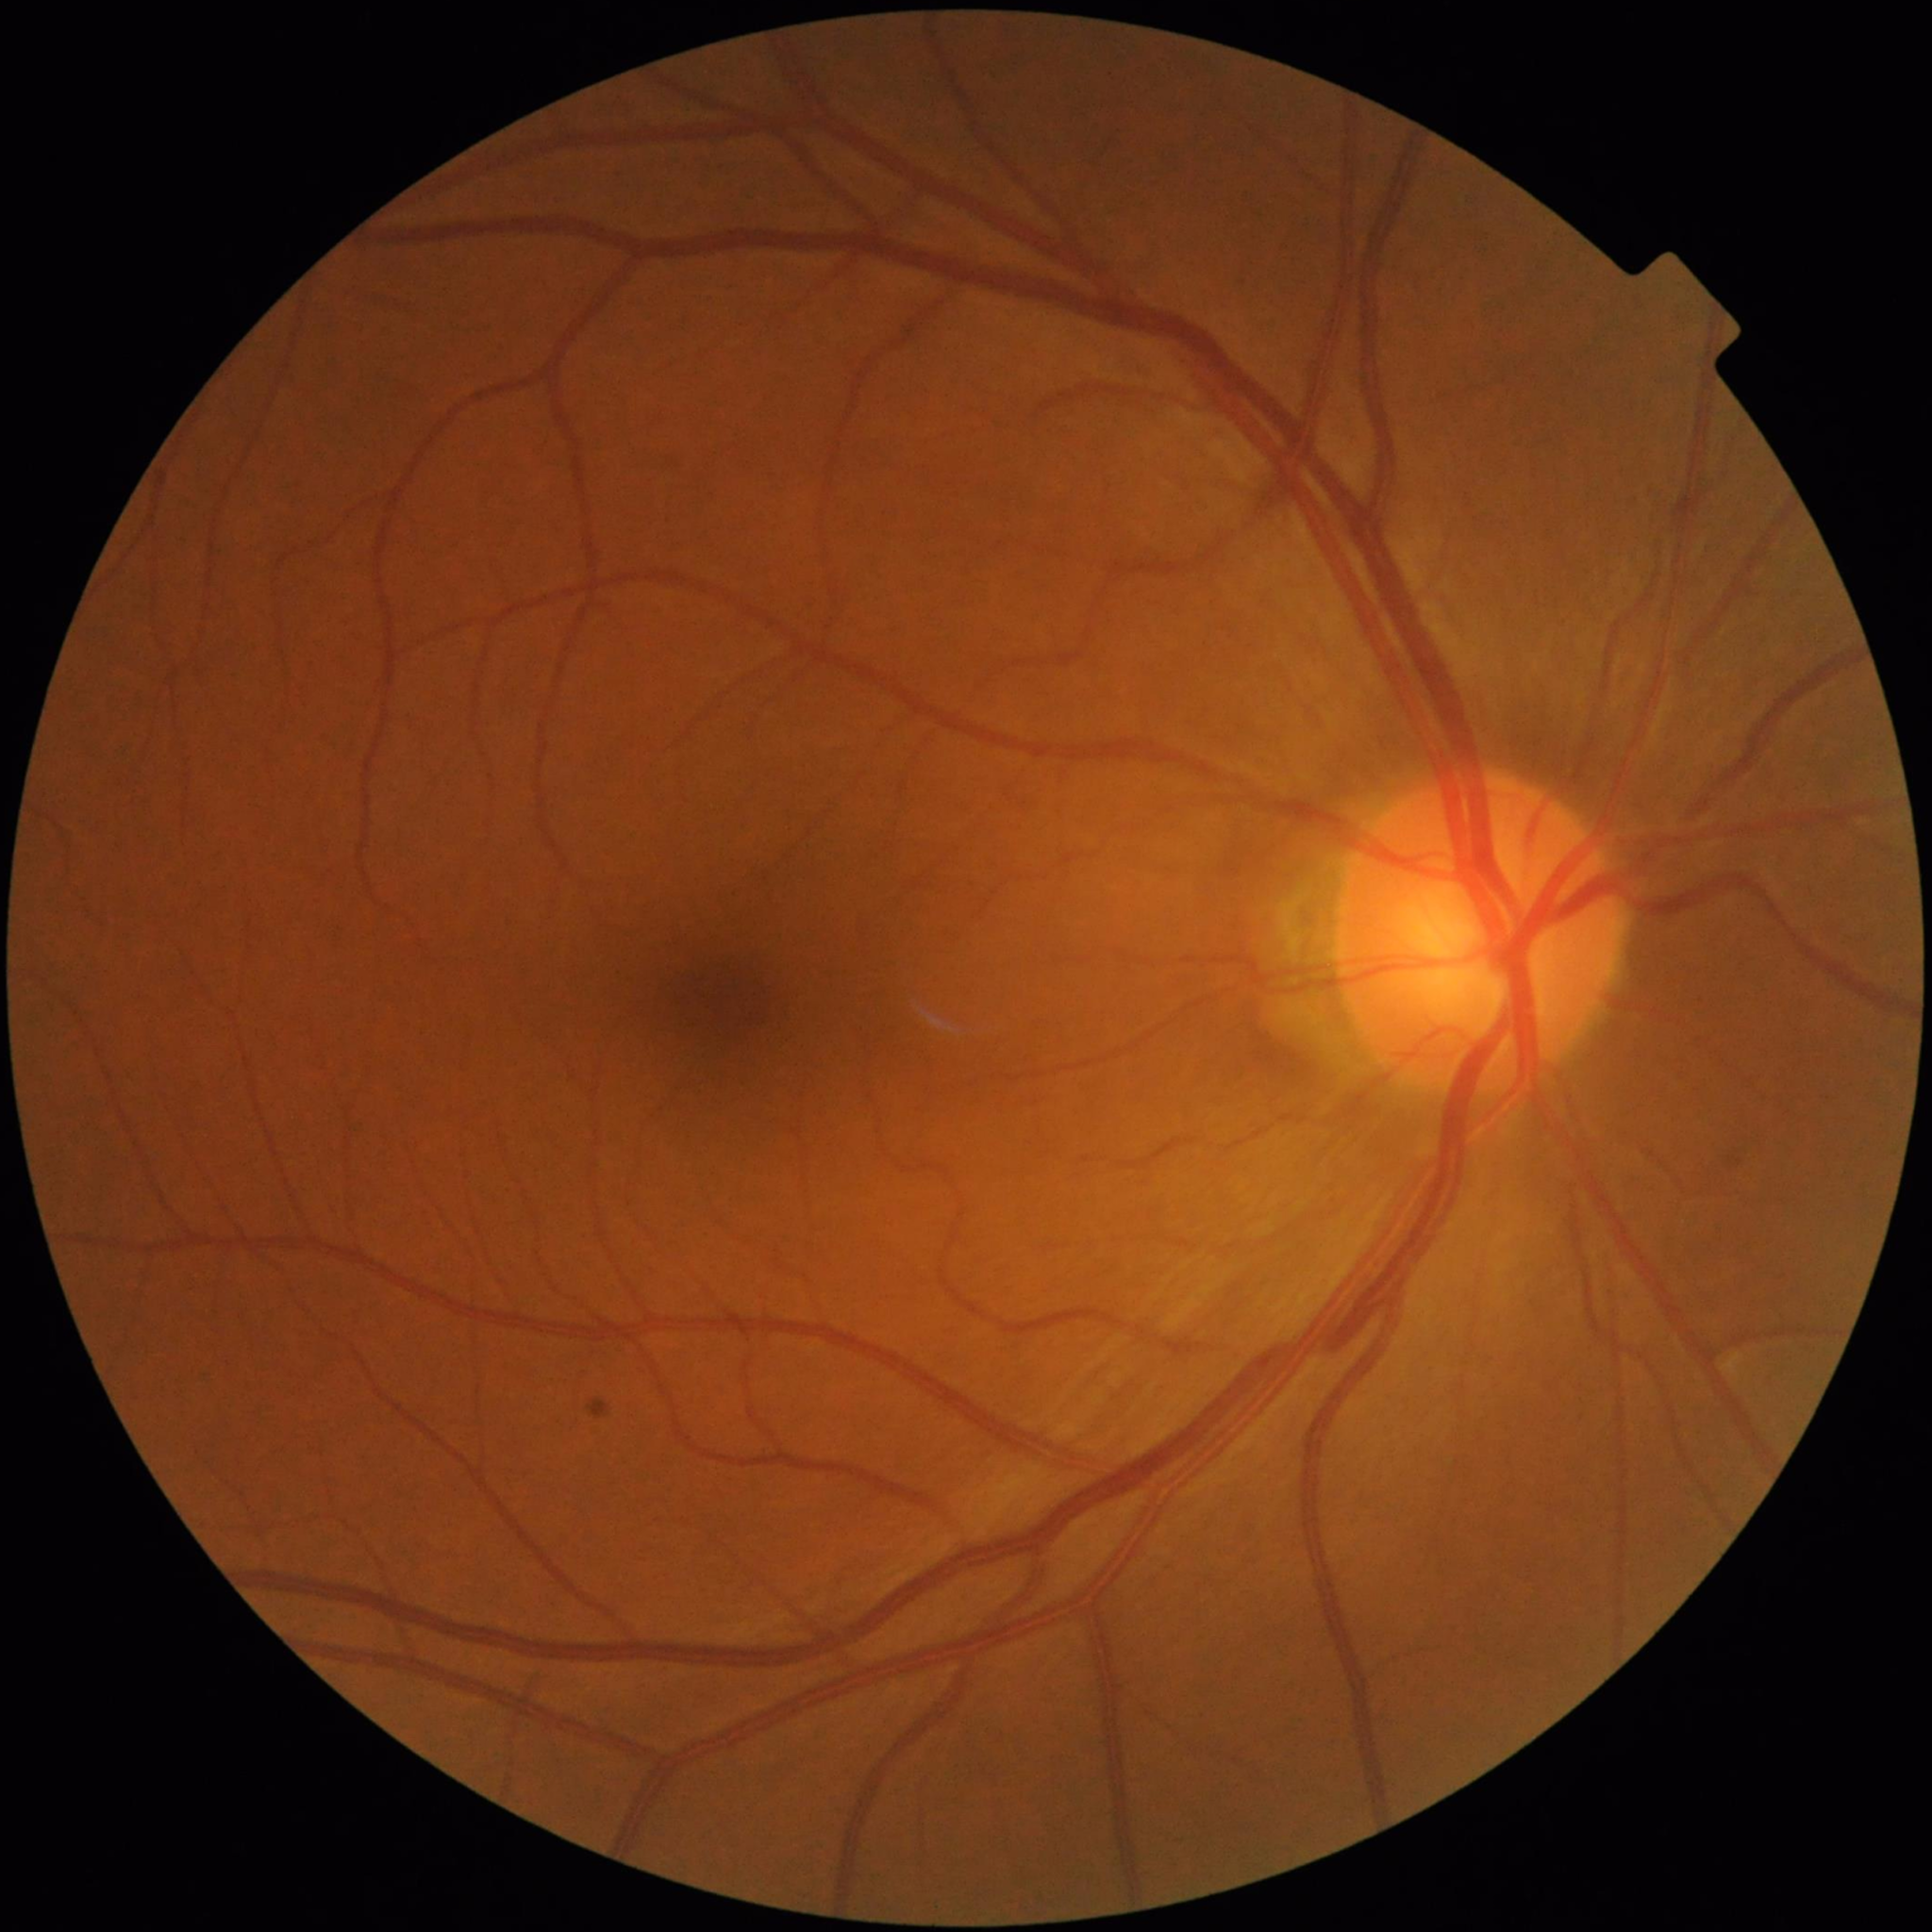
Color fundus photo from a control patient without diagnosed retinal disease.